848x848; without pupil dilation
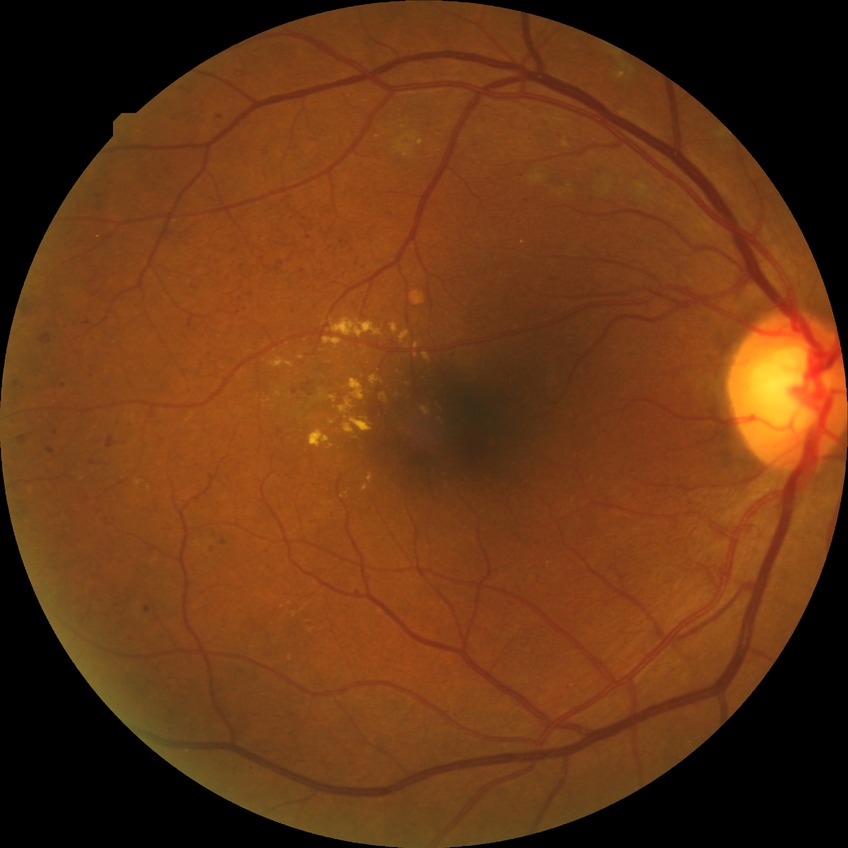

Diabetic retinopathy (DR): proliferative diabetic retinopathy (PDR).